45° FOV:
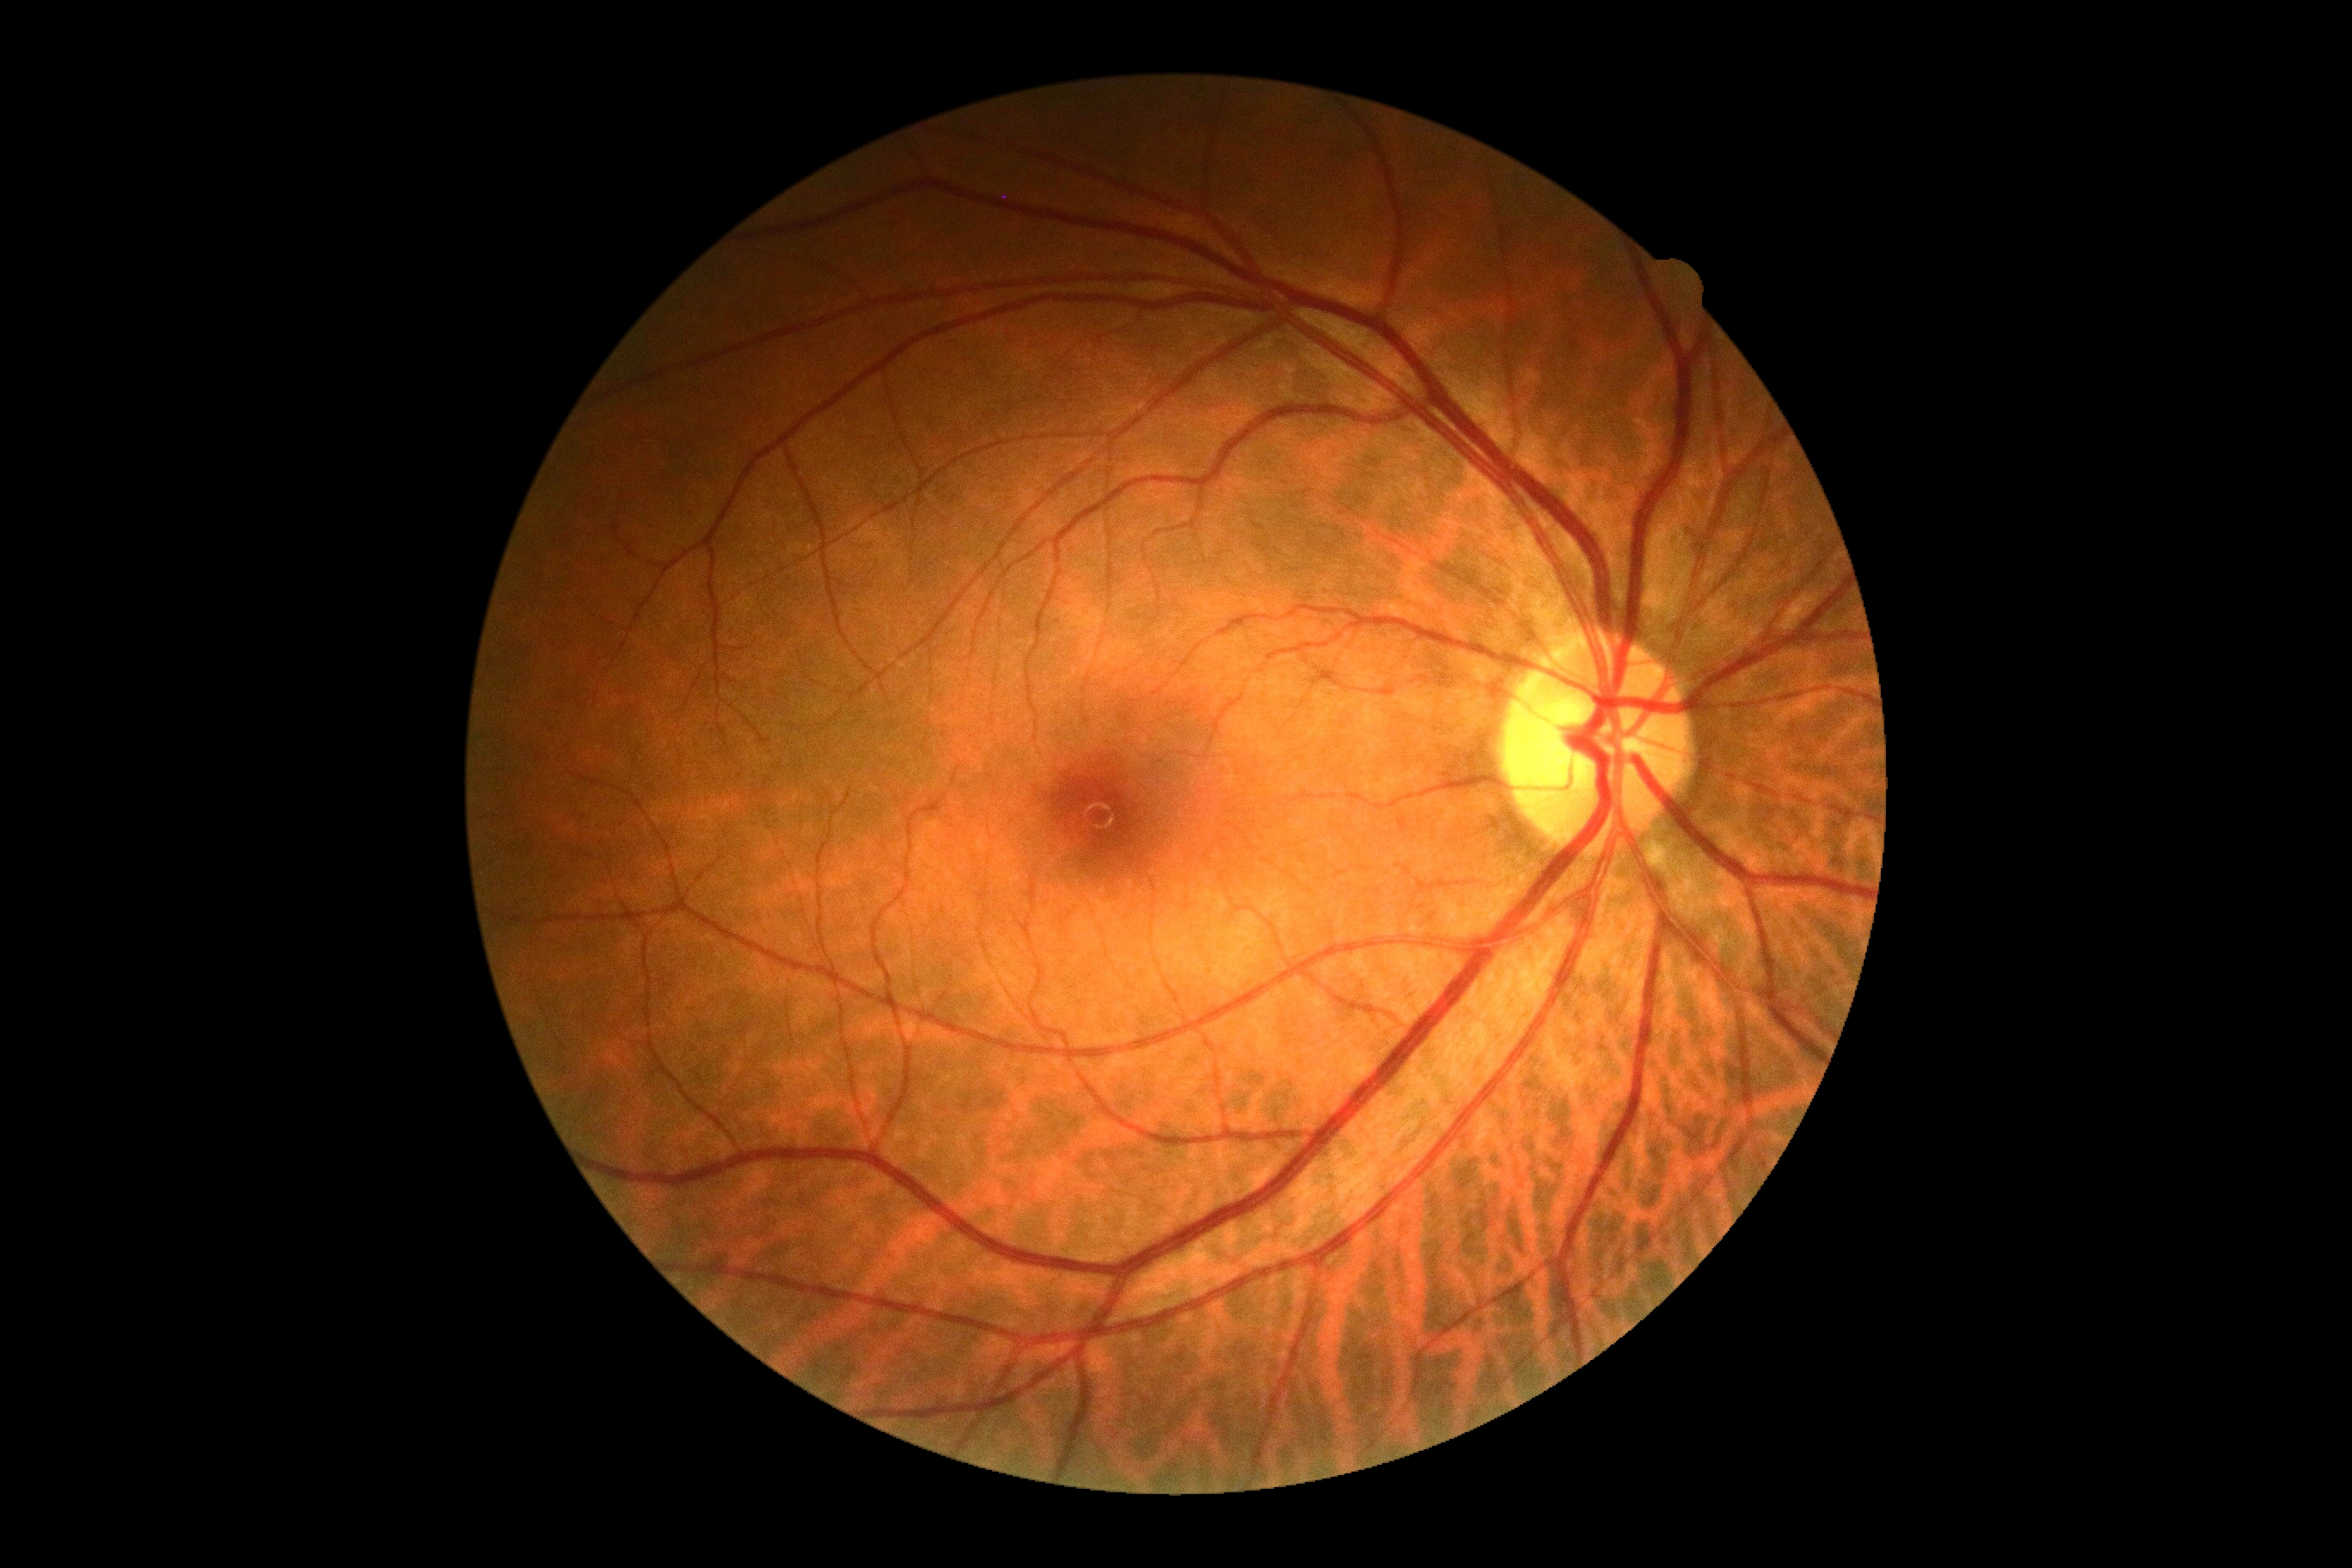 DR stage=grade 0.